FOV: 45 degrees. Fundus photo:
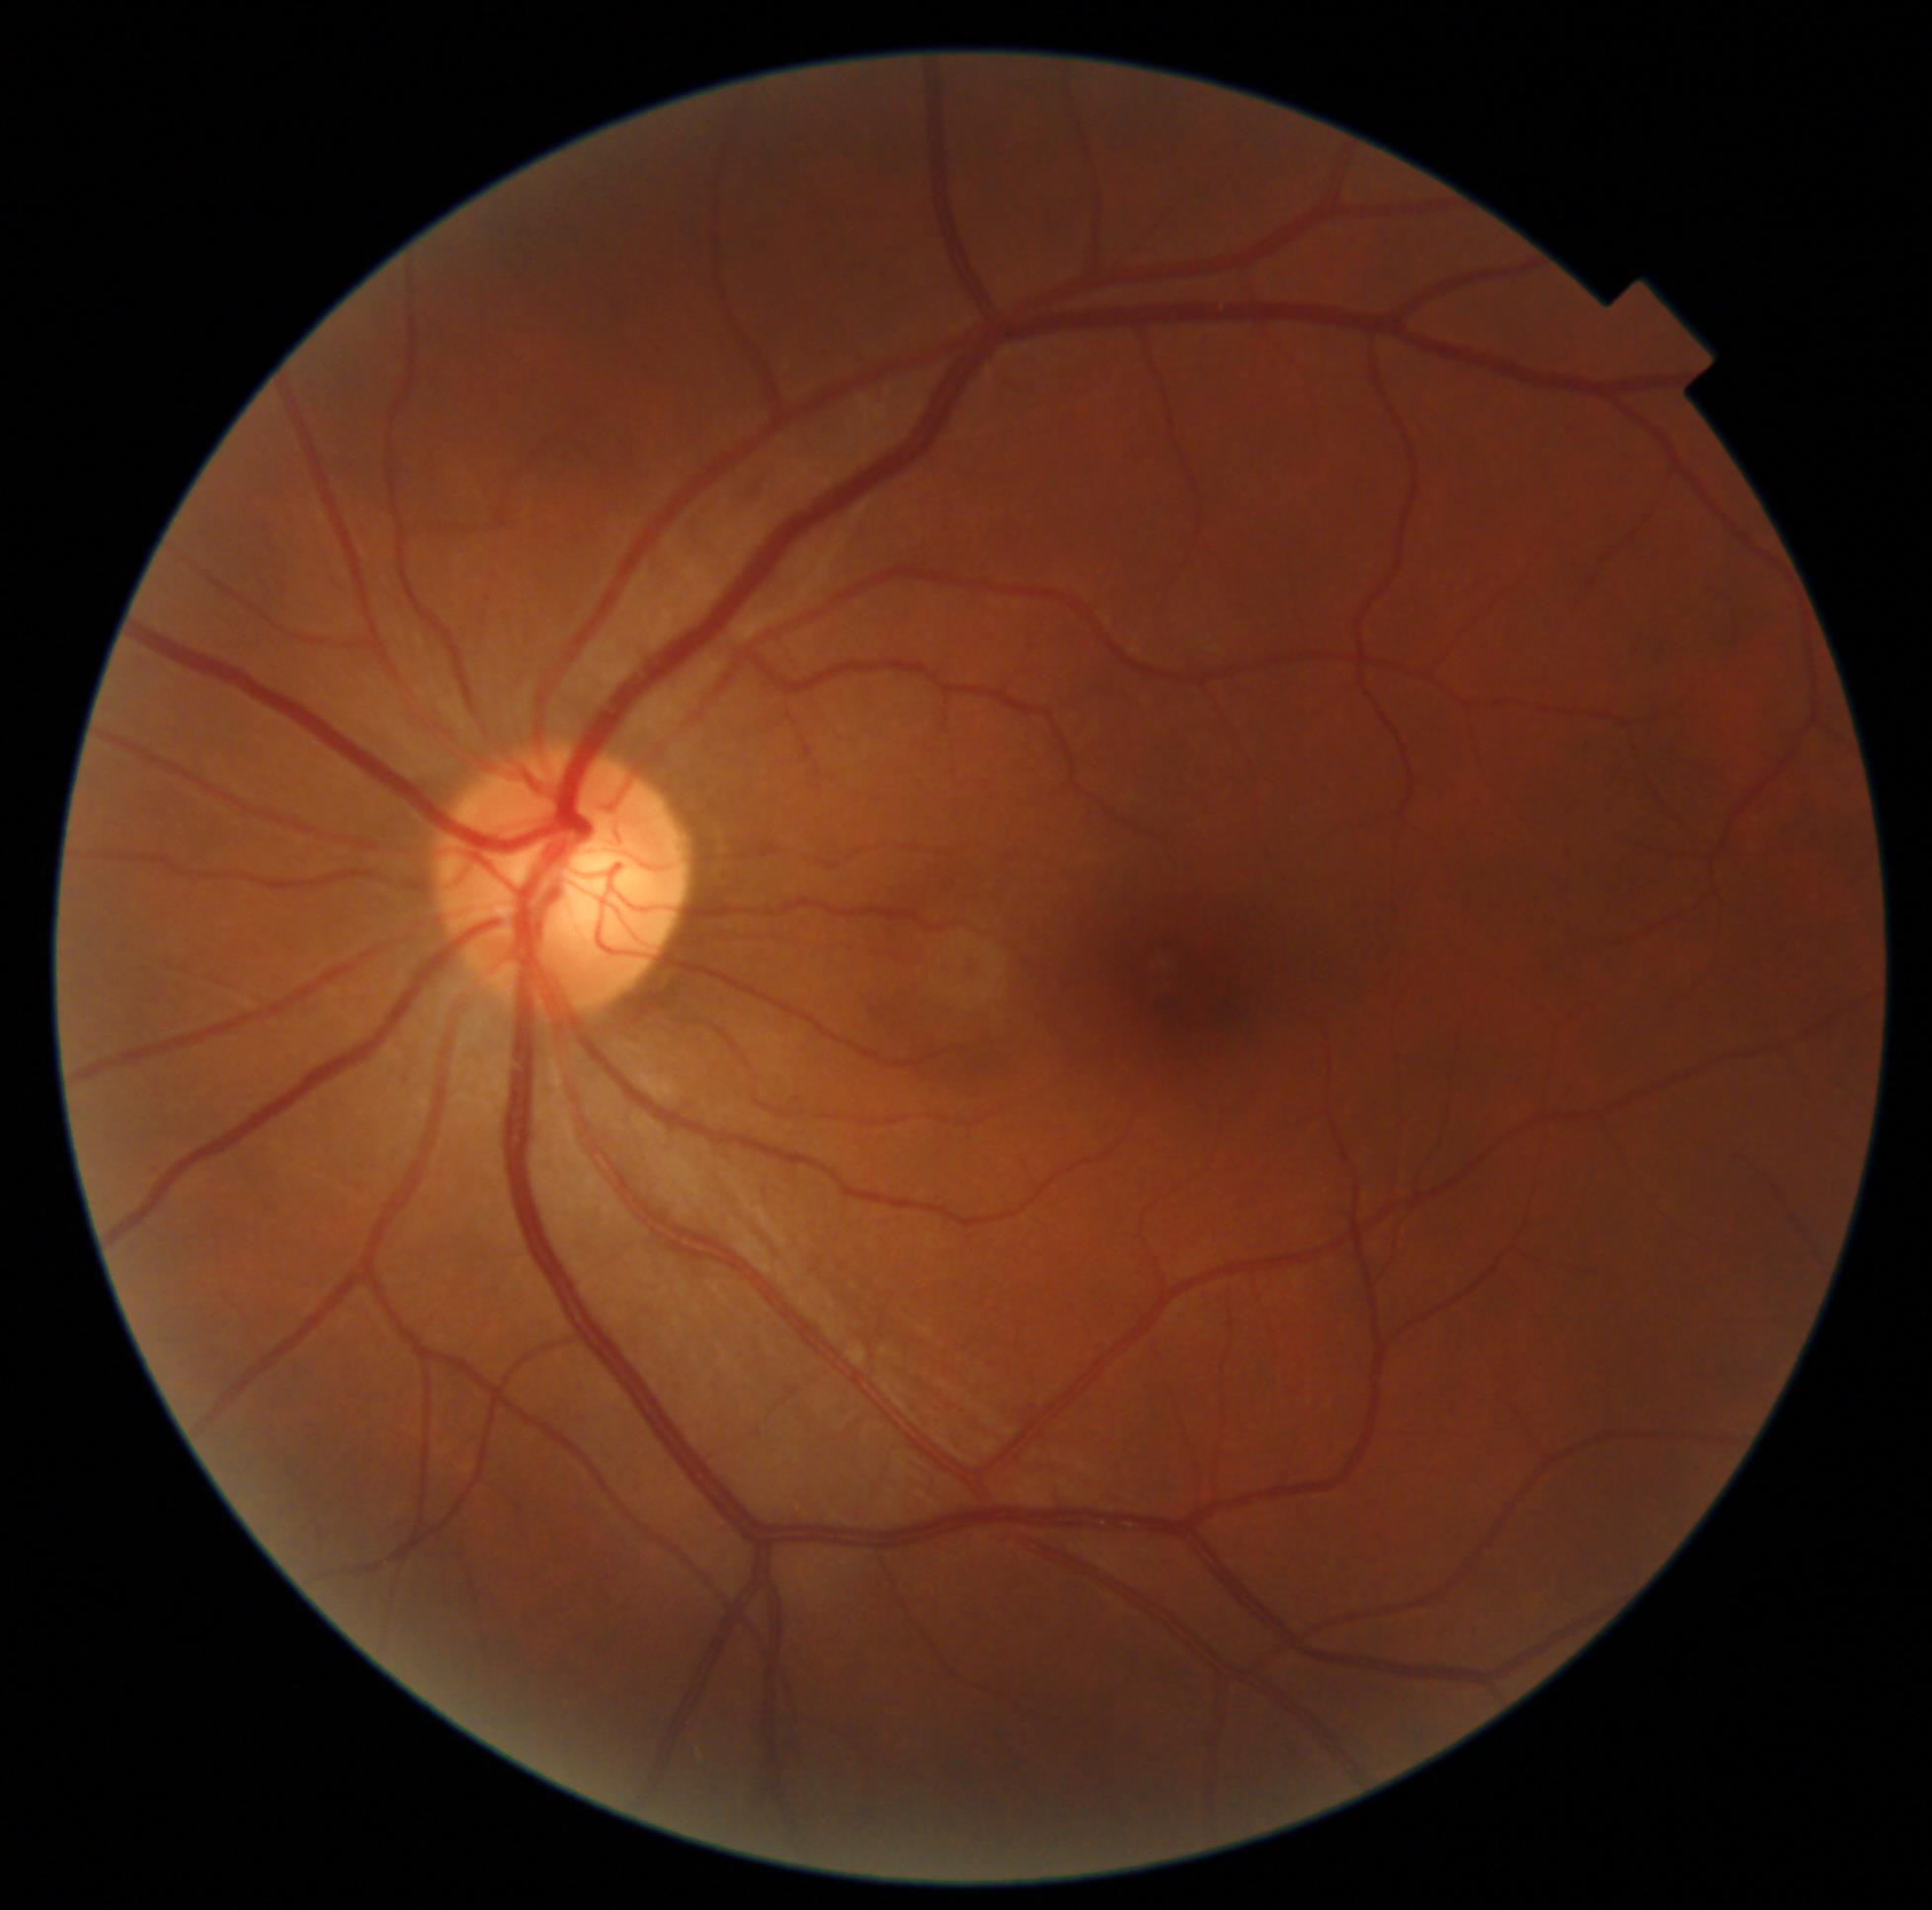 Diabetic retinopathy (DR): grade 0 (no apparent retinopathy).